Color fundus image:
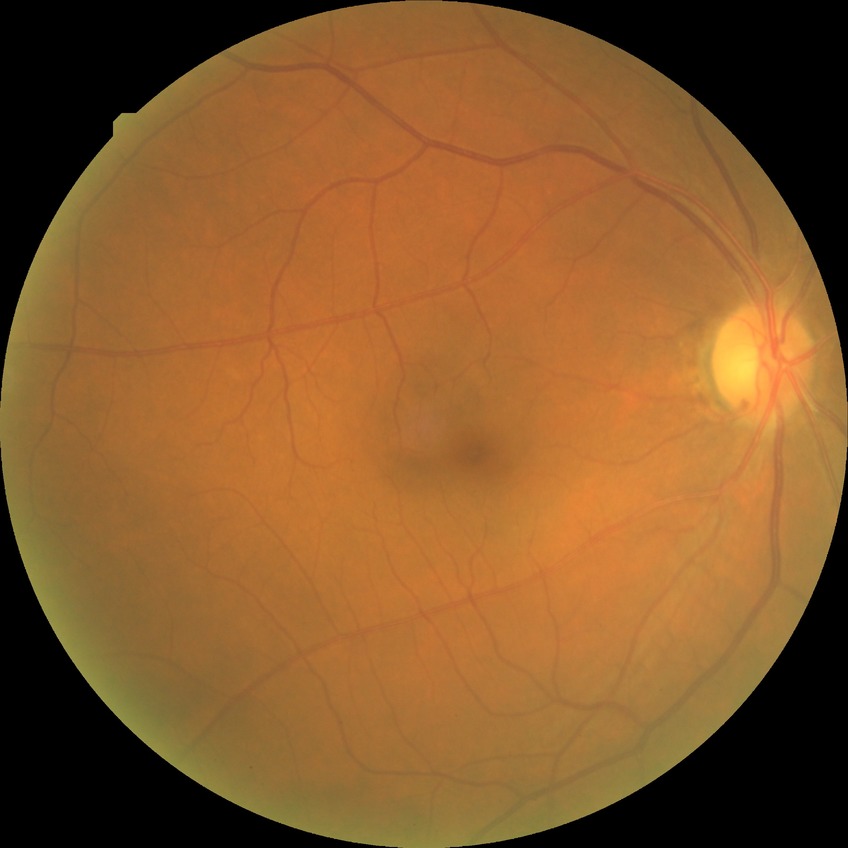
modified Davis classification: no diabetic retinopathy.